Ultra-widefield fundus mosaic — 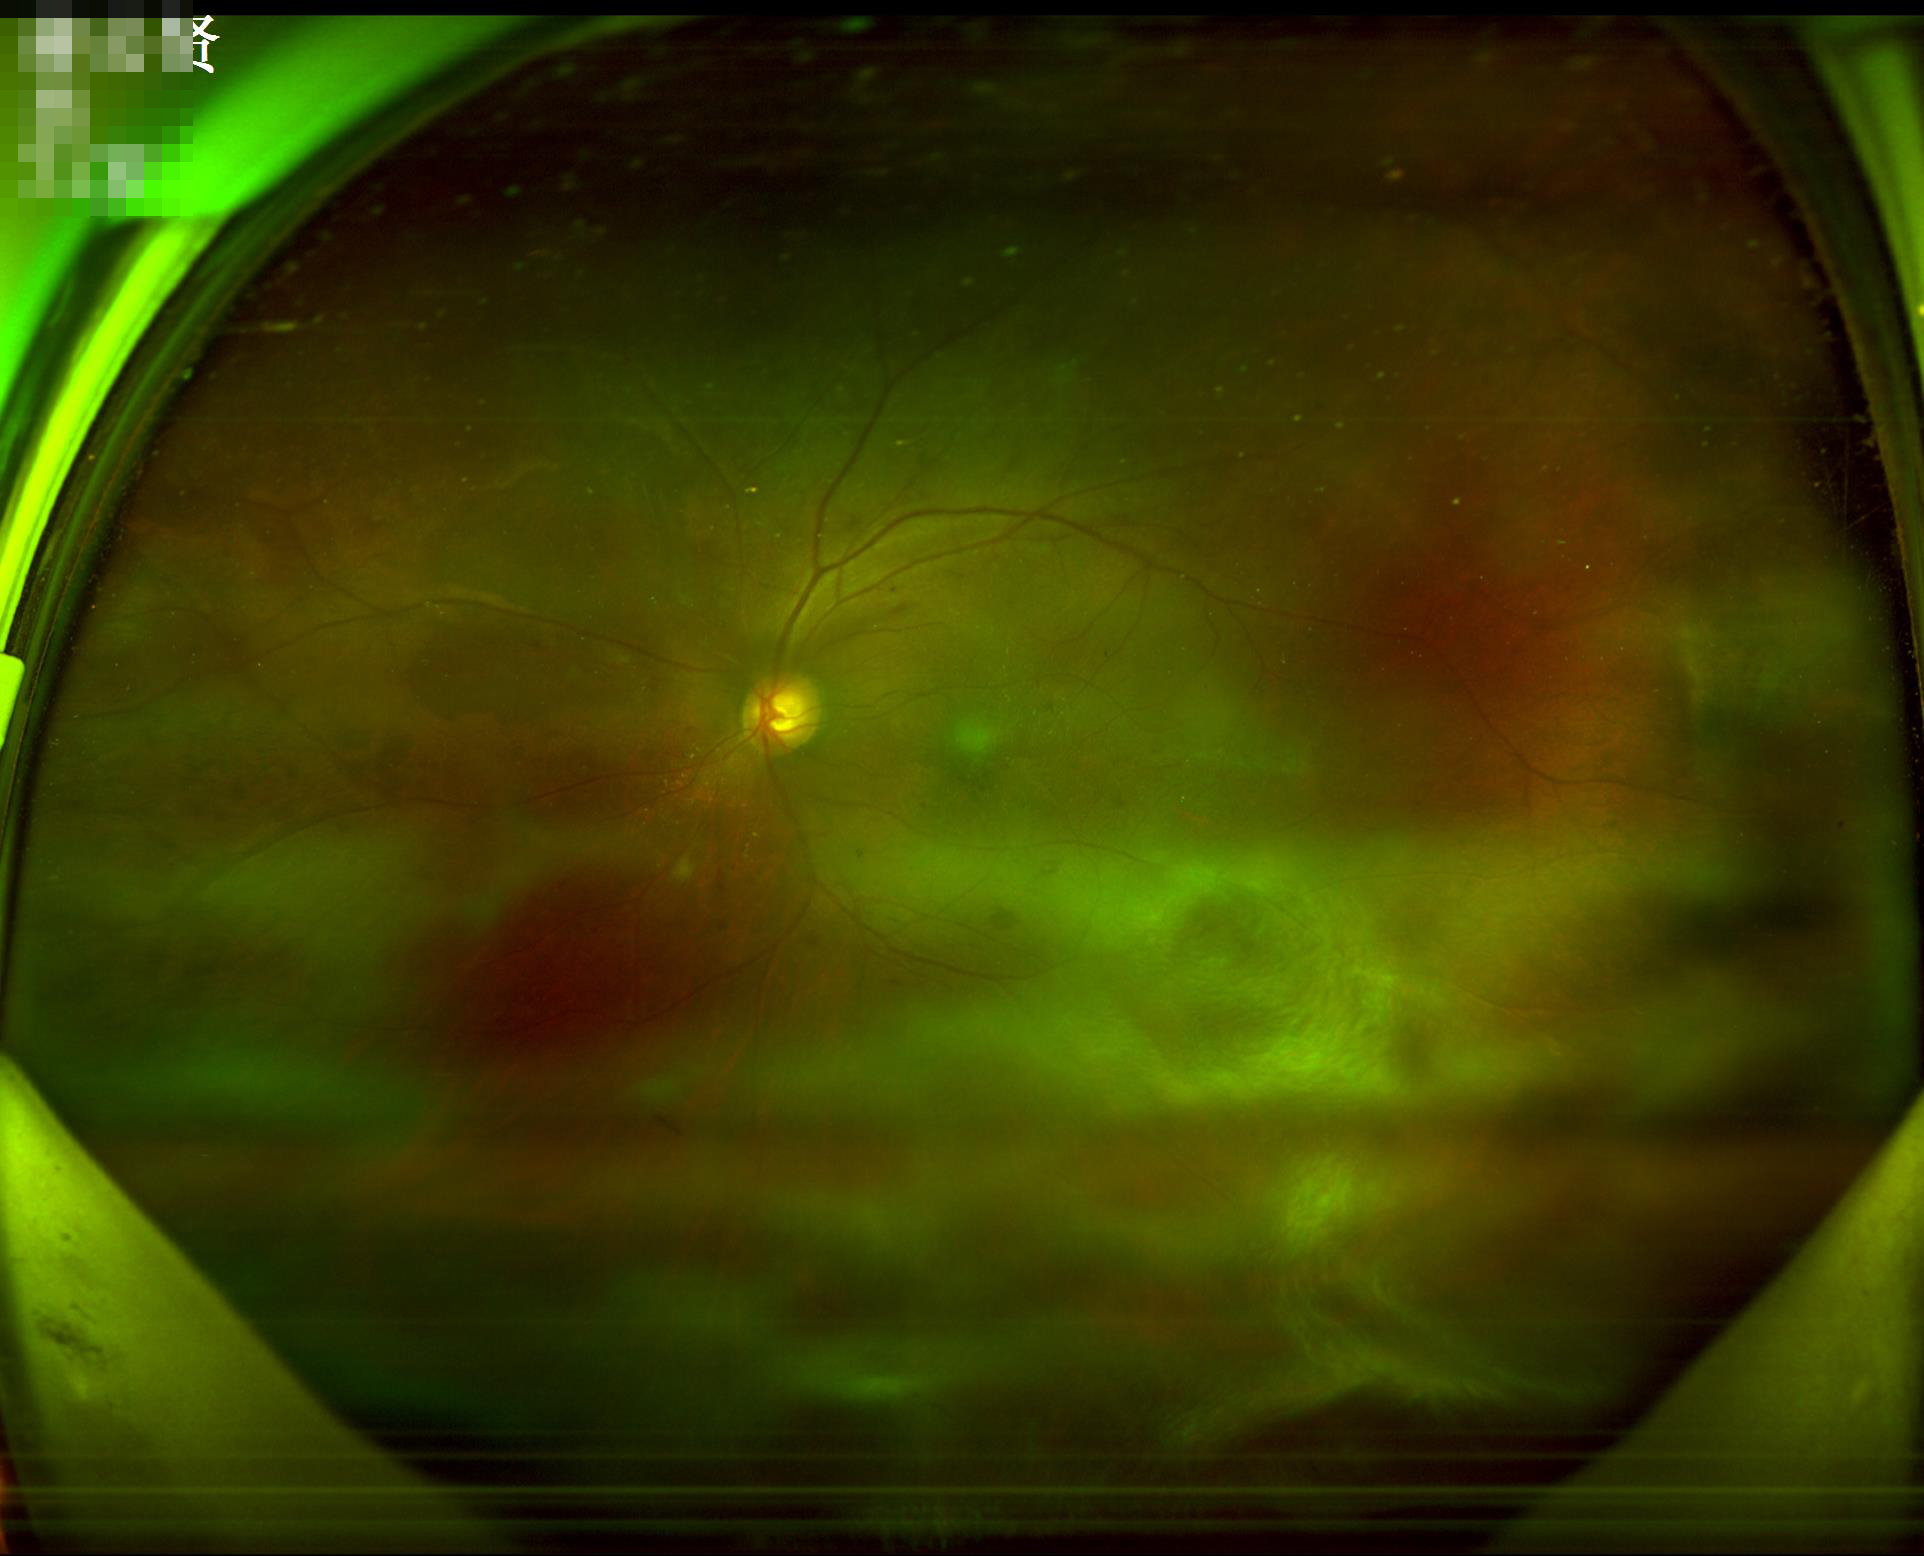

Quality assessment:
- contrast: good
- overall: good
- focus: out of focus
- illumination/color: even